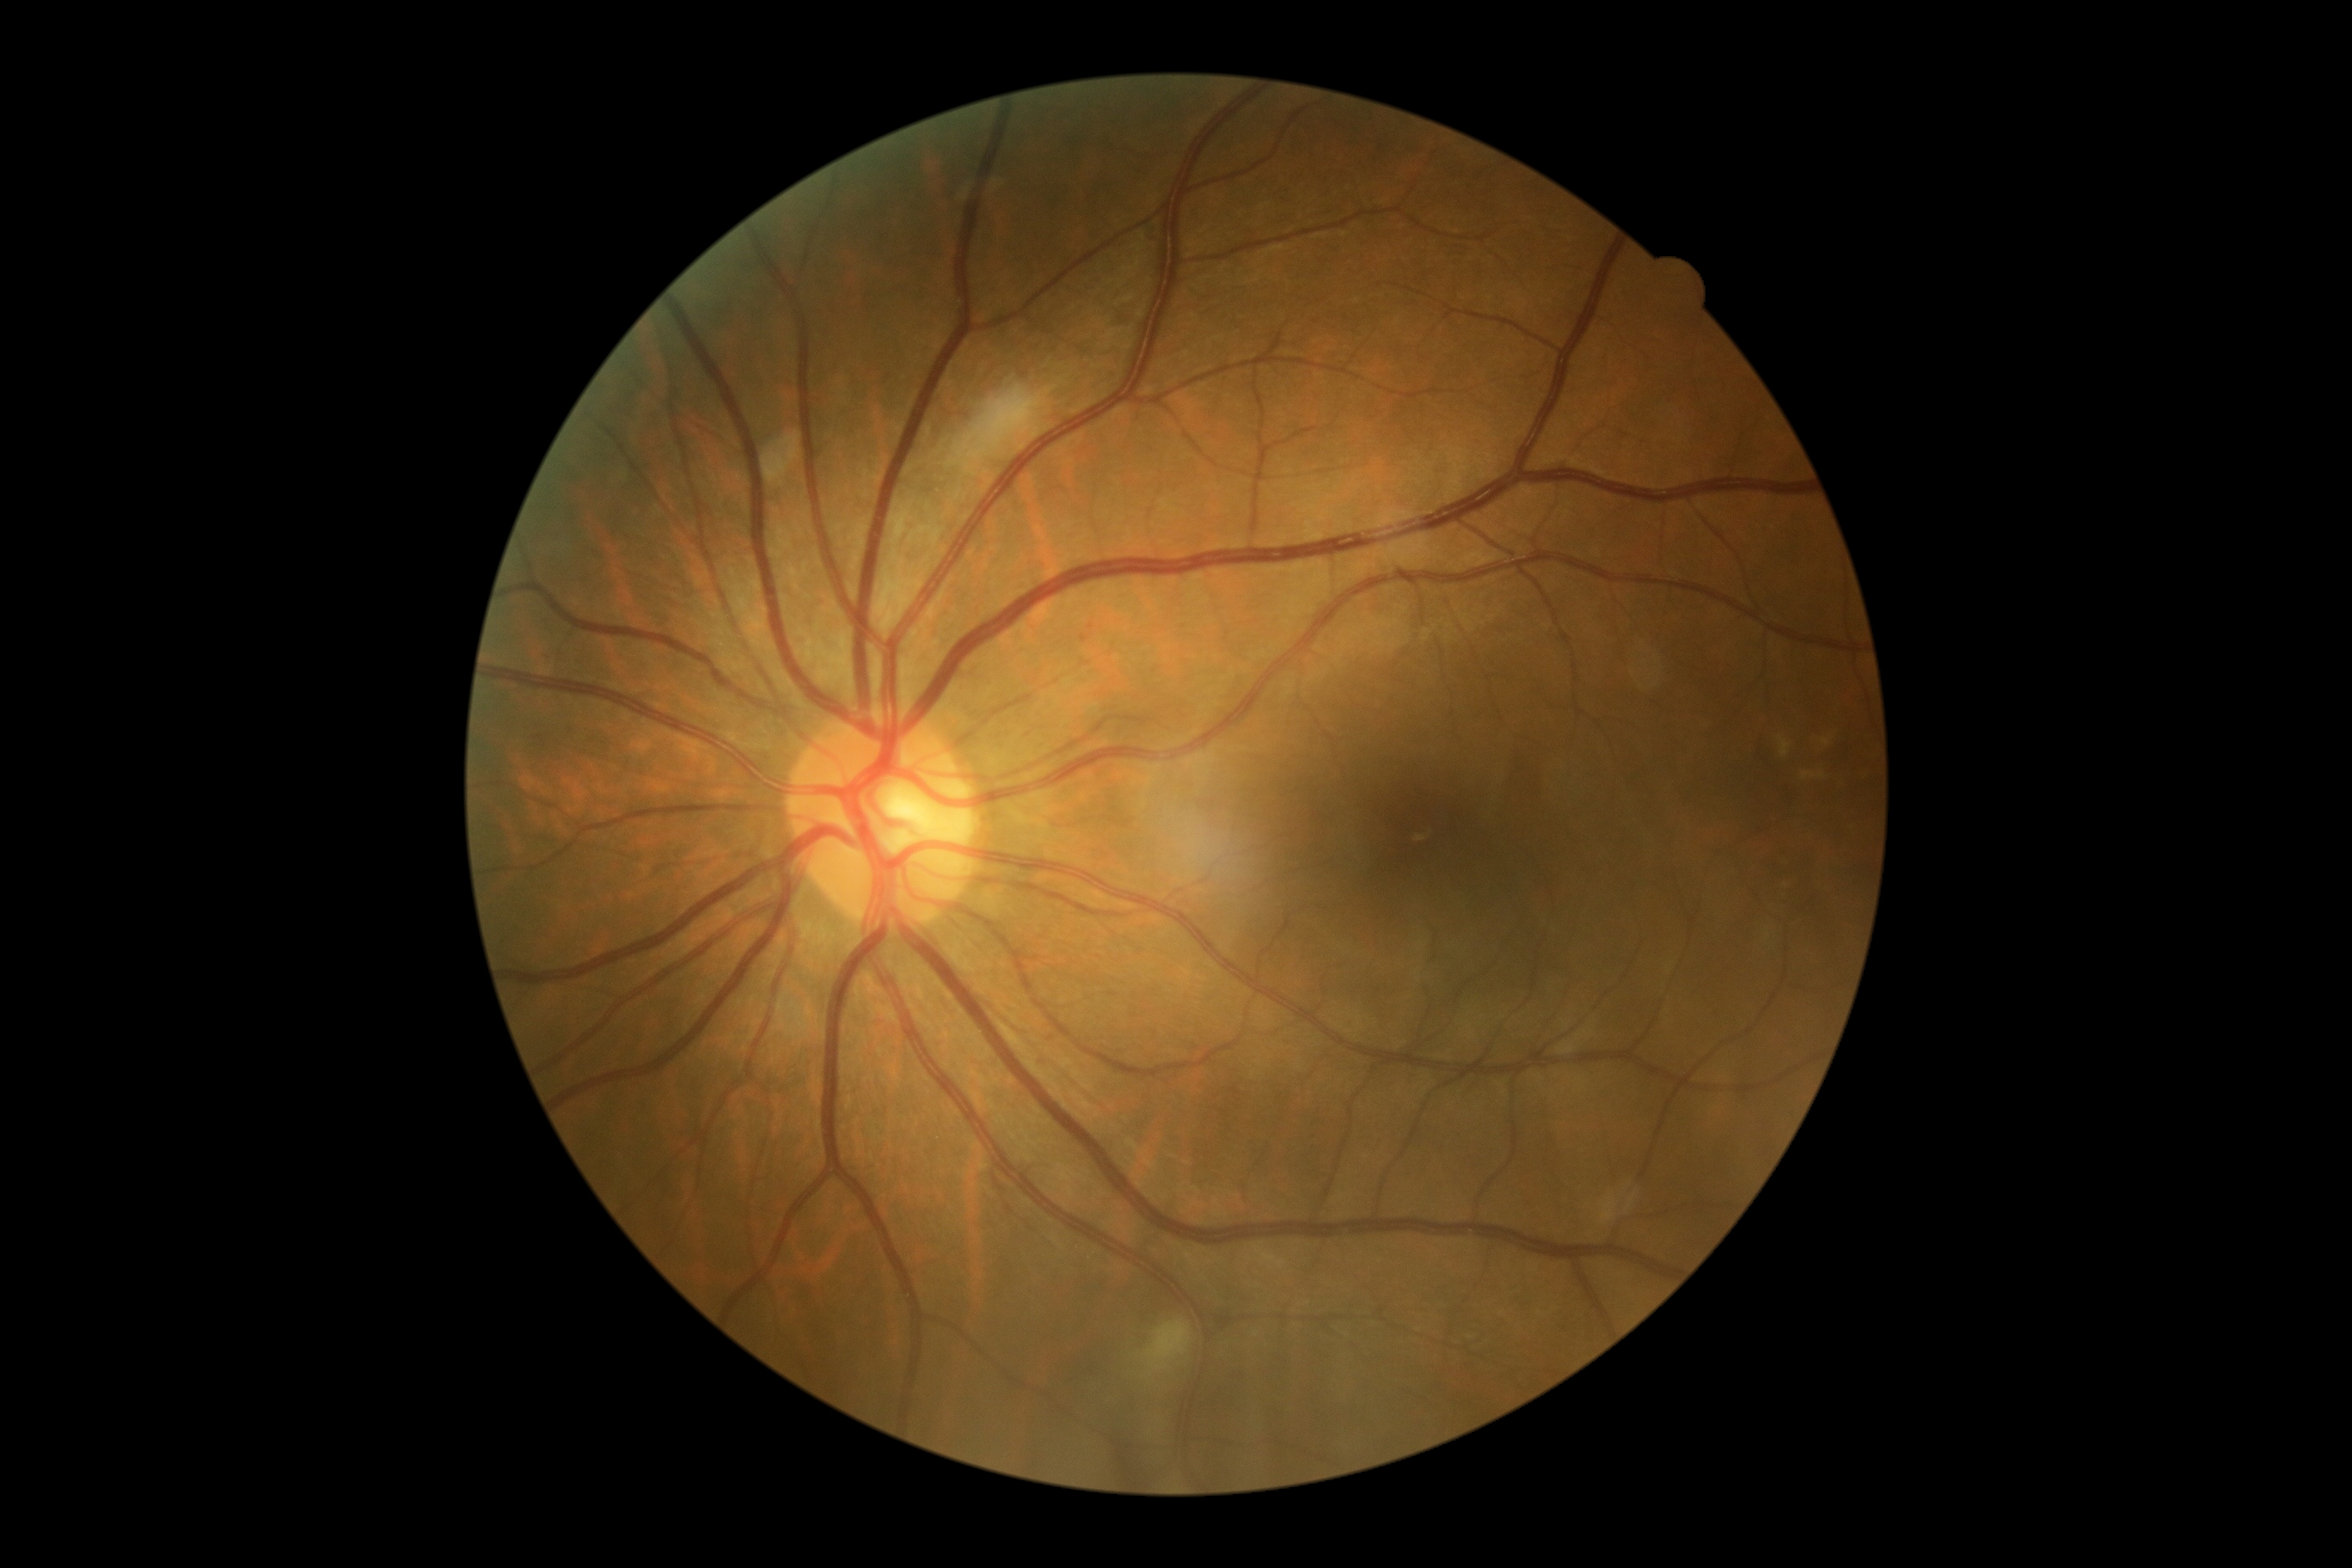

DR severity: 2/4.
Disease class: non-proliferative diabetic retinopathy.